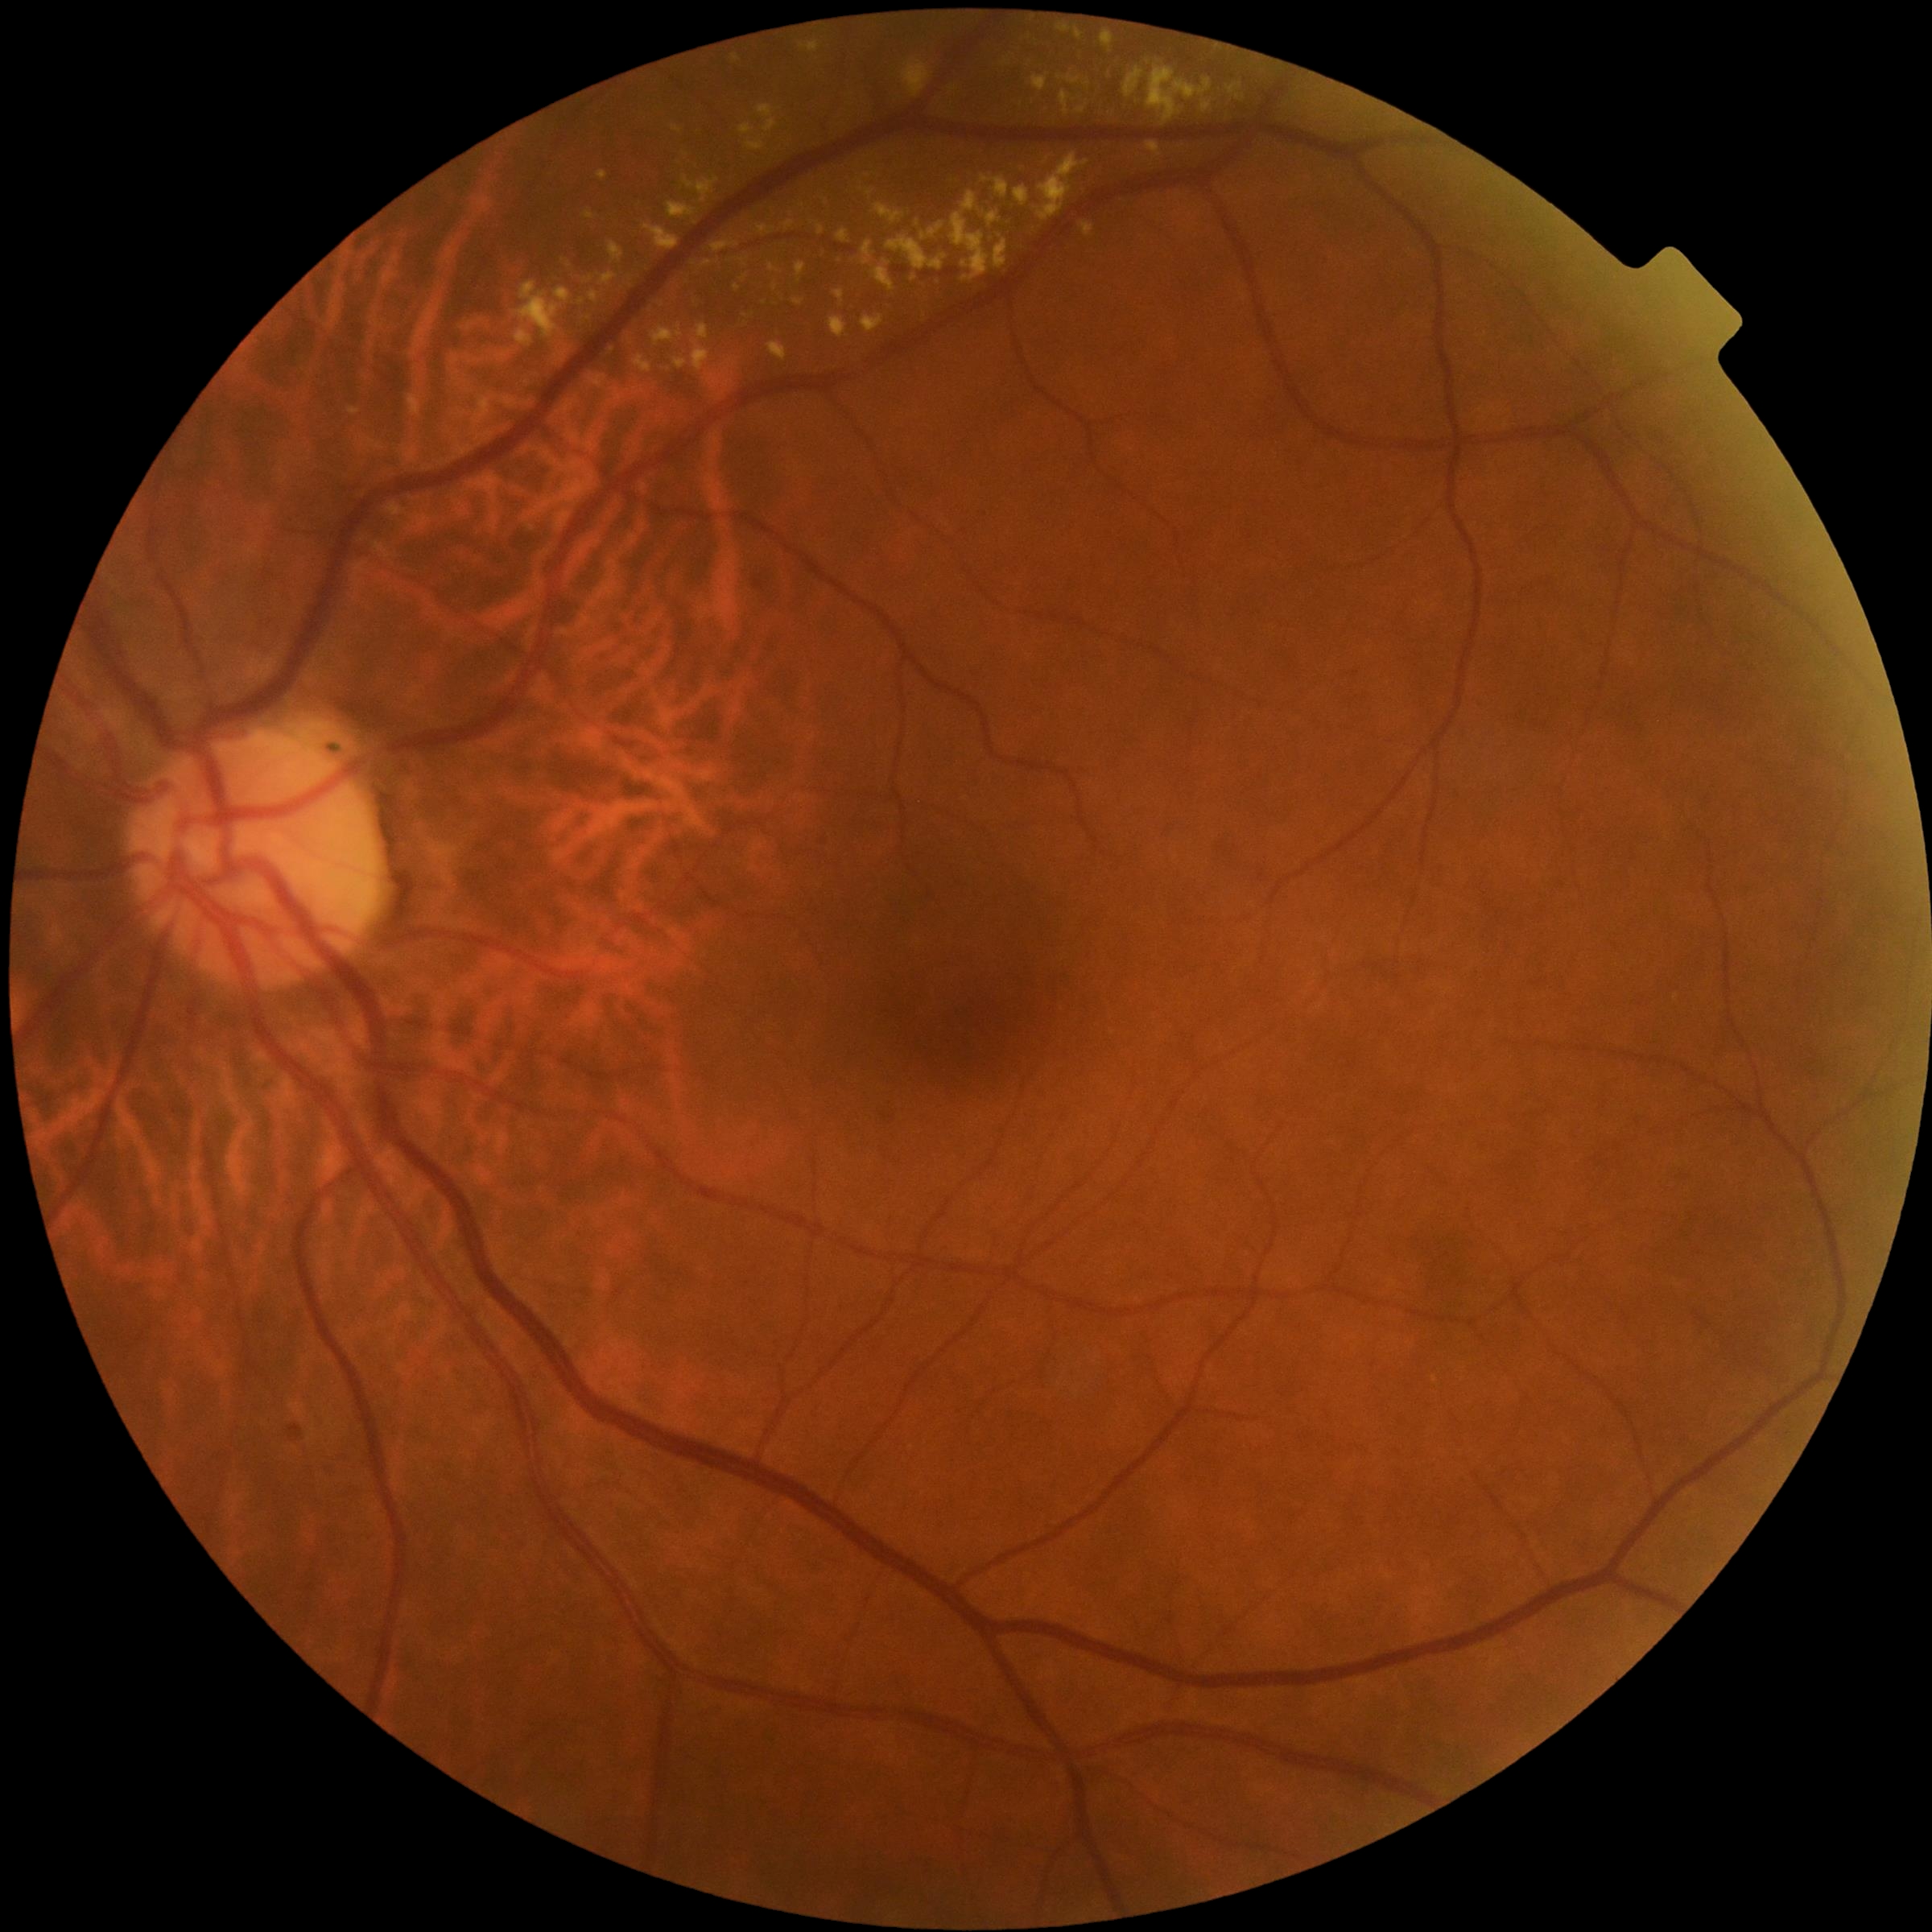 Diabetic retinopathy grade: 2/4
Selected lesions:
• hard exudates (more not shown): (995,178,1010,200); (1226,84,1243,101); (513,281,572,349); (740,123,755,137); (644,225,679,251); (706,375,721,386); (785,221,795,230); (1059,20,1071,33); (757,105,779,133); (862,315,885,334); (1033,75,1048,92); (770,264,779,272); (1076,30,1082,39); (578,298,586,306)
• Hard exudates (small, approximate centers) near <pt>669,369</pt>; <pt>985,181</pt>; <pt>1087,84</pt>